Davis DR grading, 848x848px, camera: NIDEK AFC-230, nonmydriatic, 45 degree fundus photograph — 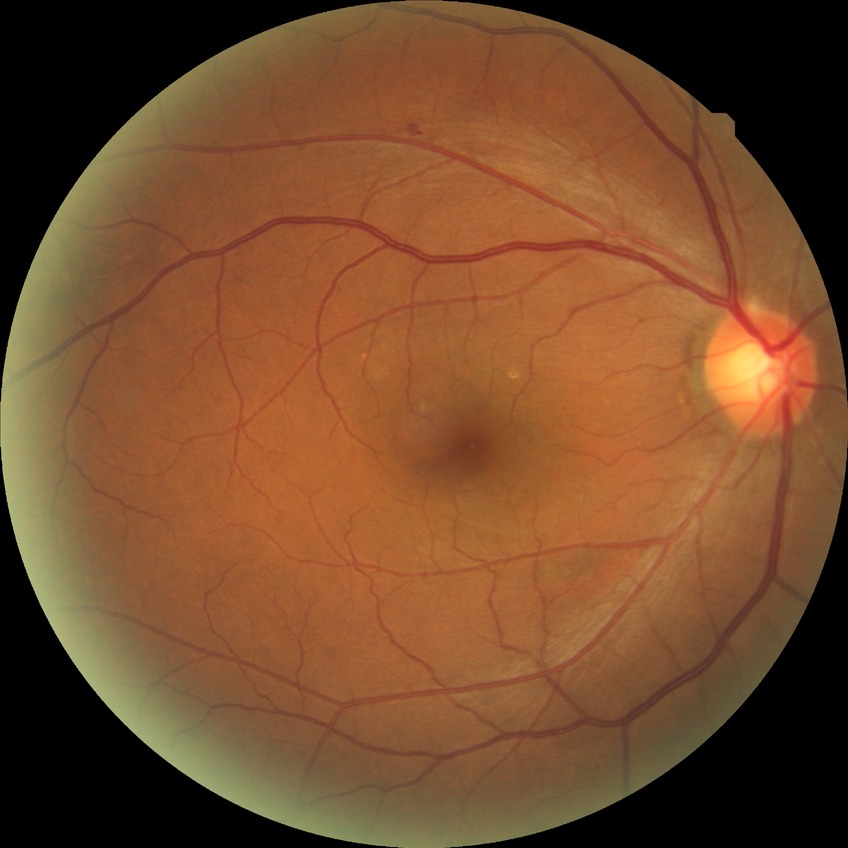 Diabetic retinopathy (DR) is no diabetic retinopathy (NDR).